Fundus photo
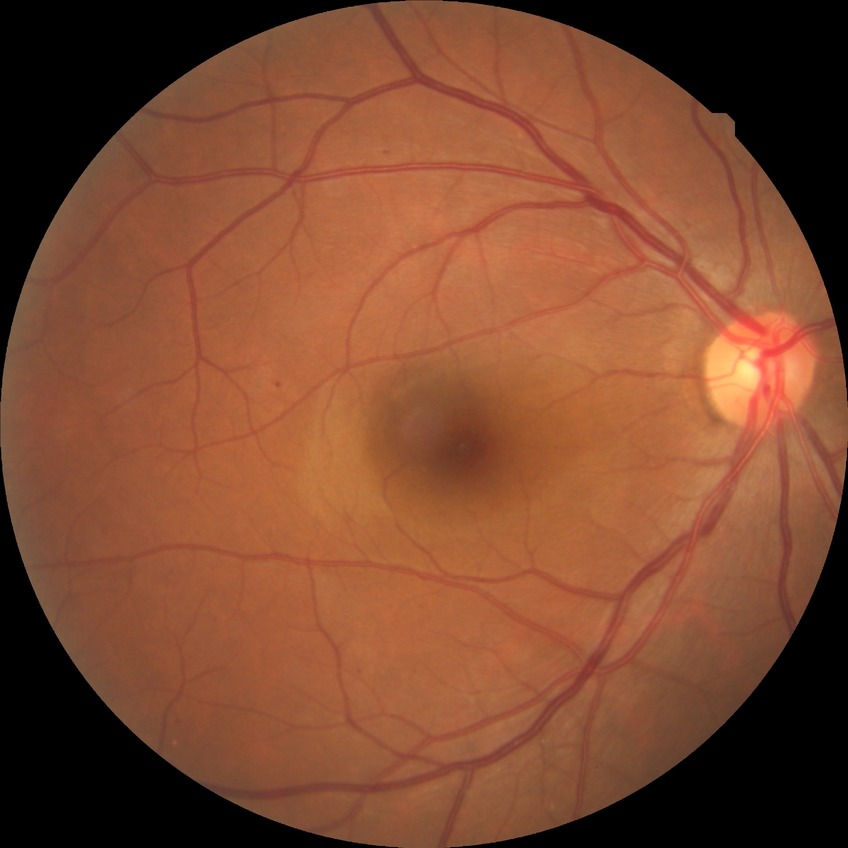
Assessment:
– DR class — non-proliferative diabetic retinopathy
– diabetic retinopathy stage — simple diabetic retinopathy